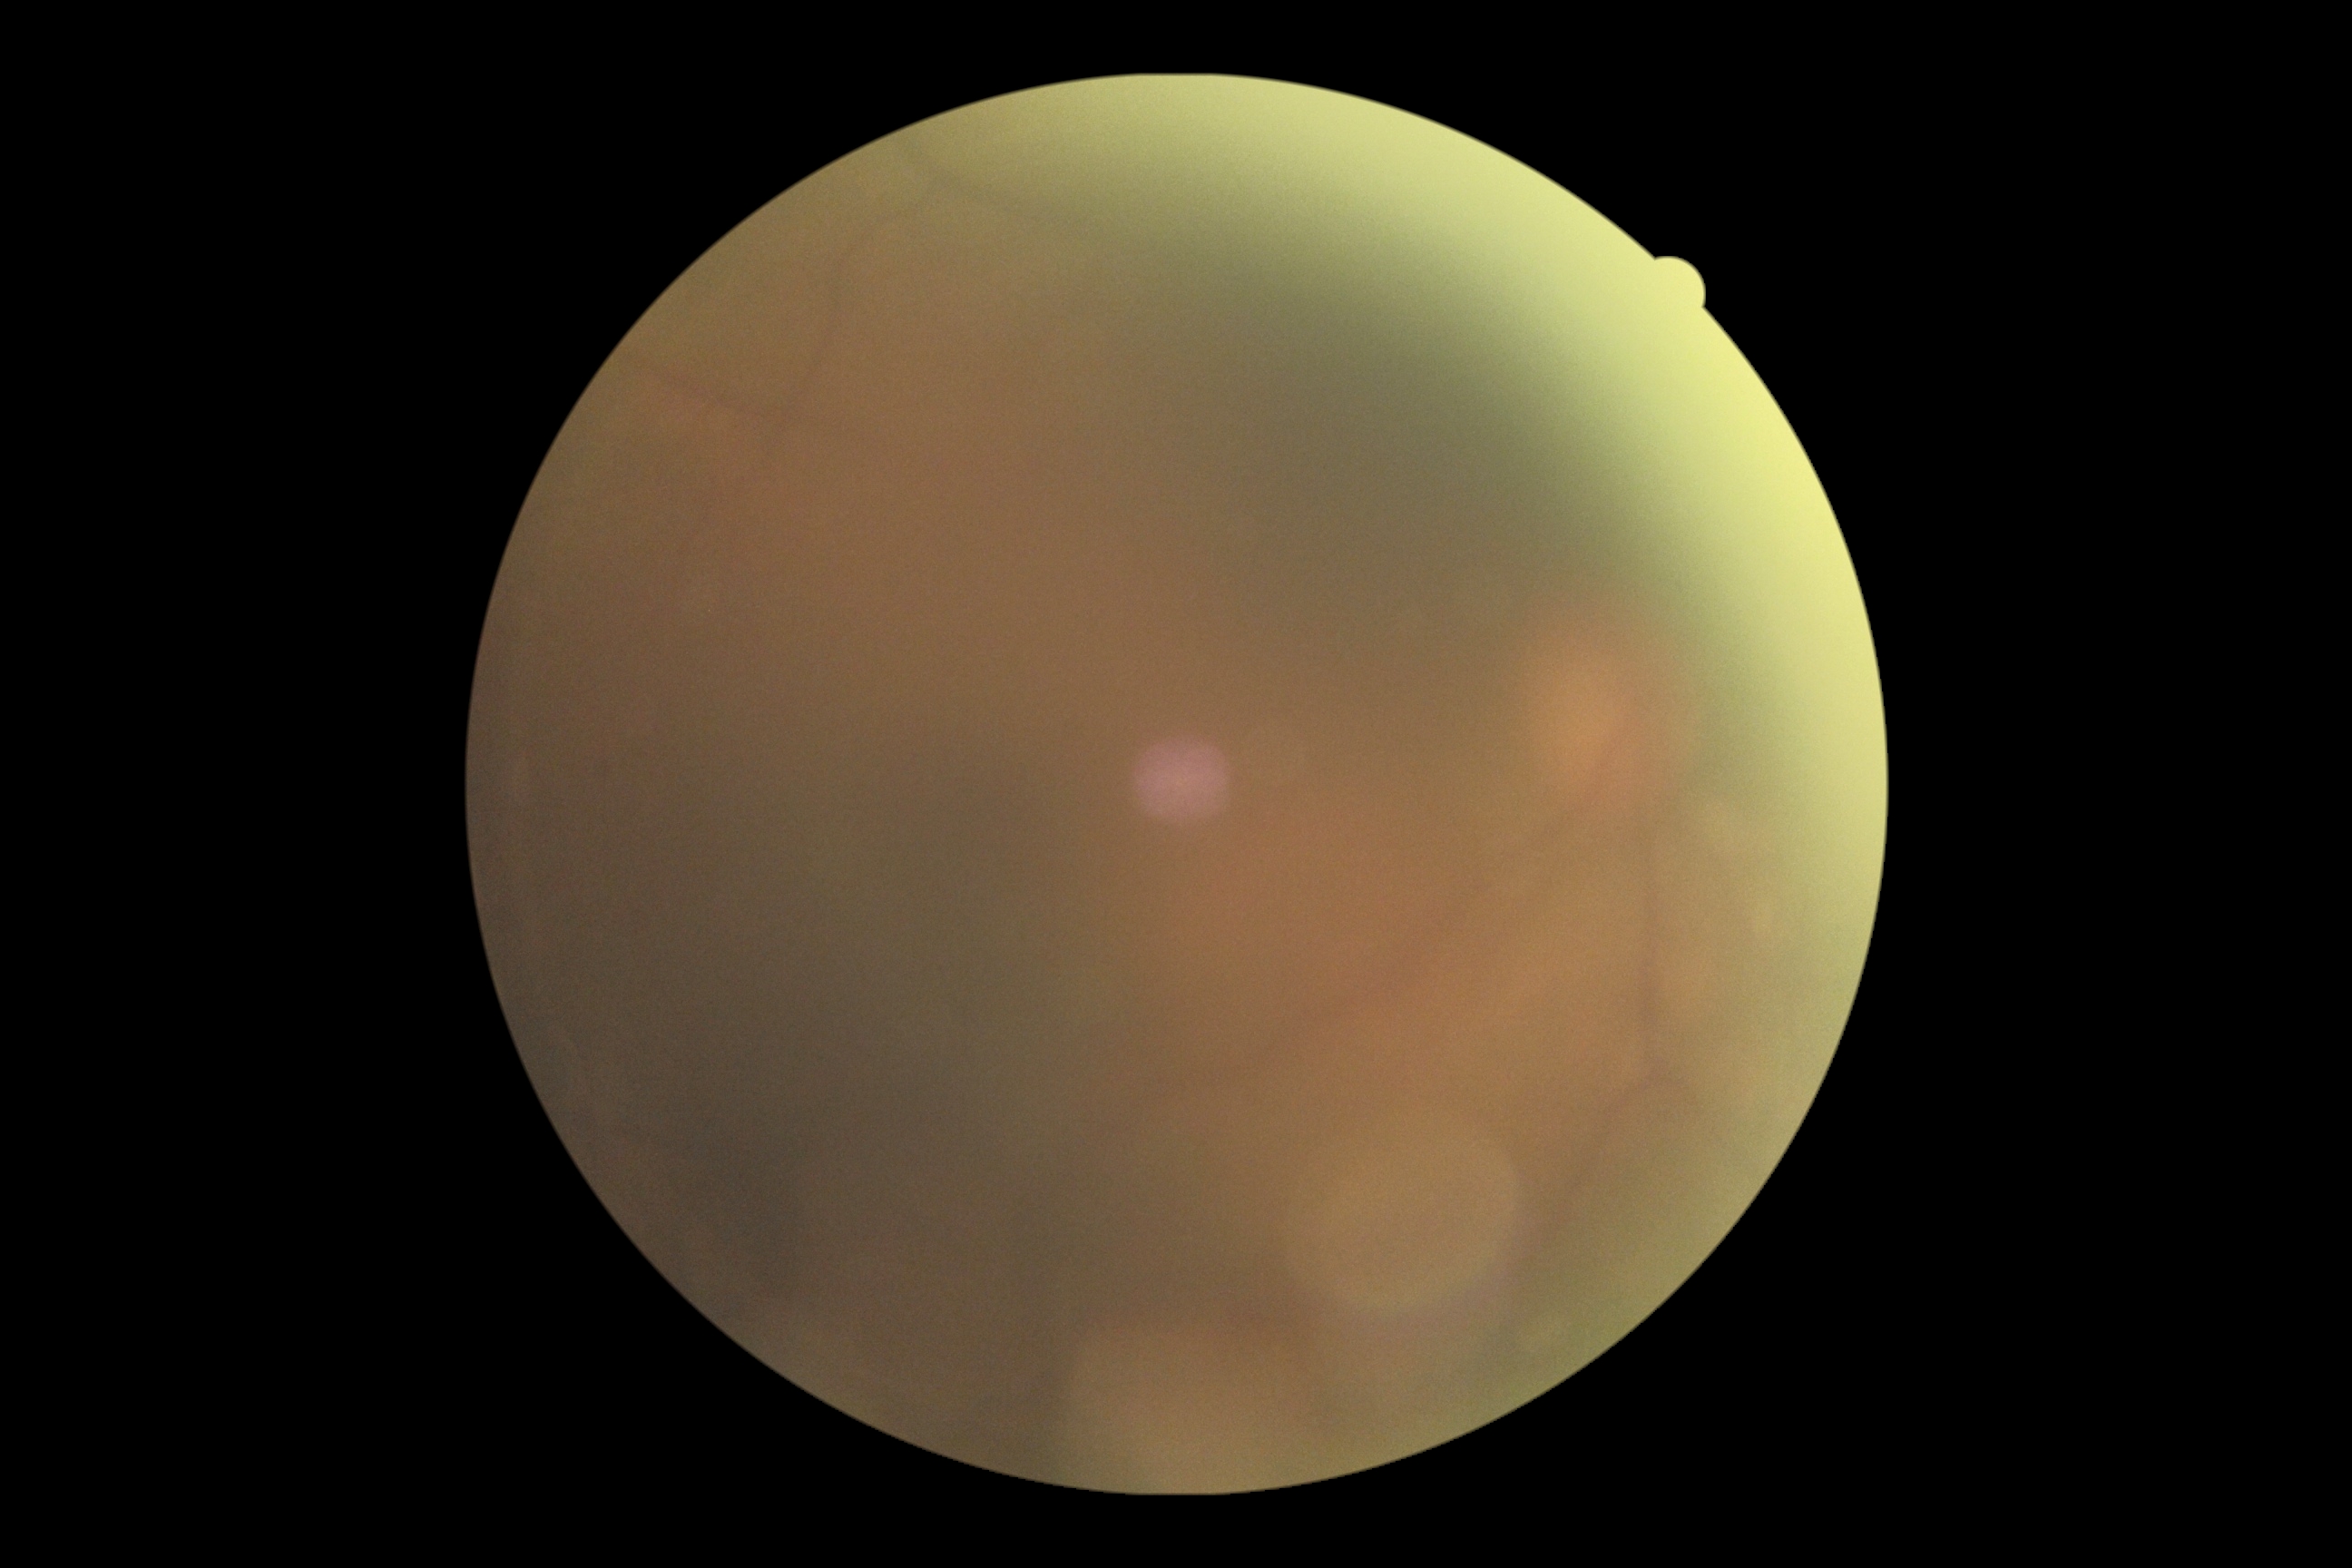 dr_grade: ungradable due to poor image quality